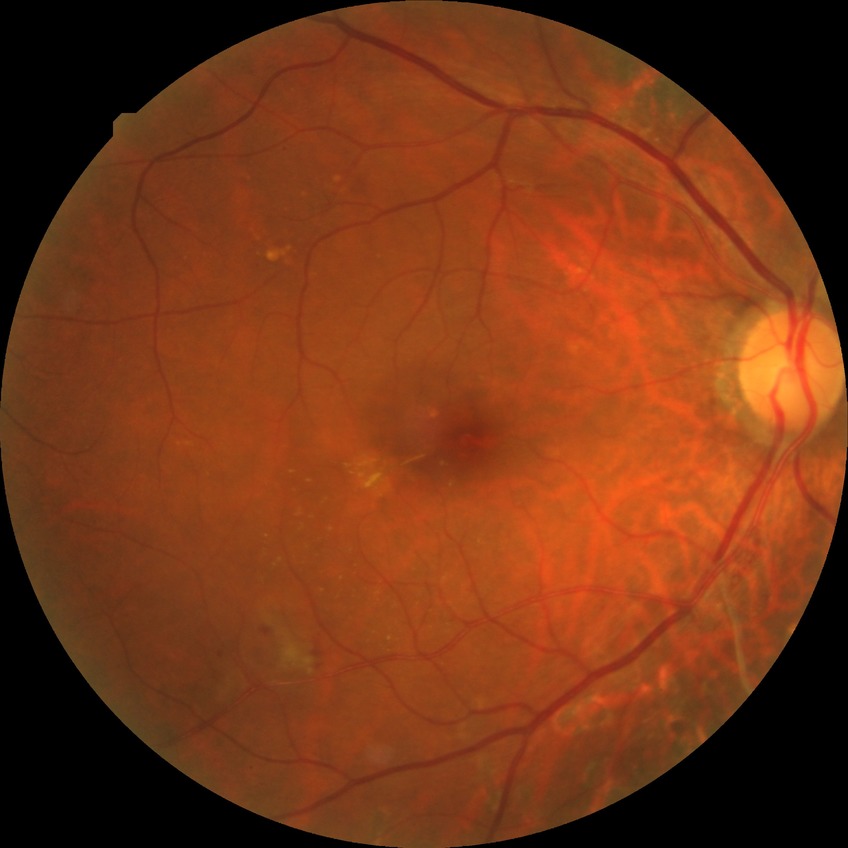
diabetic retinopathy (DR): pre-proliferative diabetic retinopathy (PPDR), DR class: non-proliferative diabetic retinopathy.